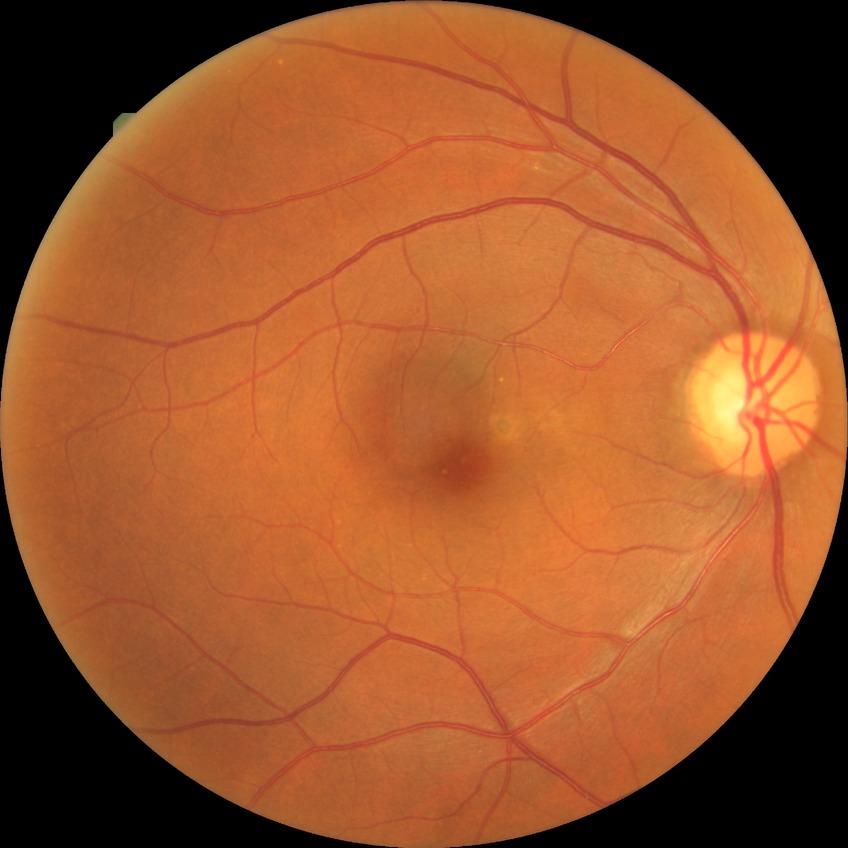 Davis grading is no diabetic retinopathy.